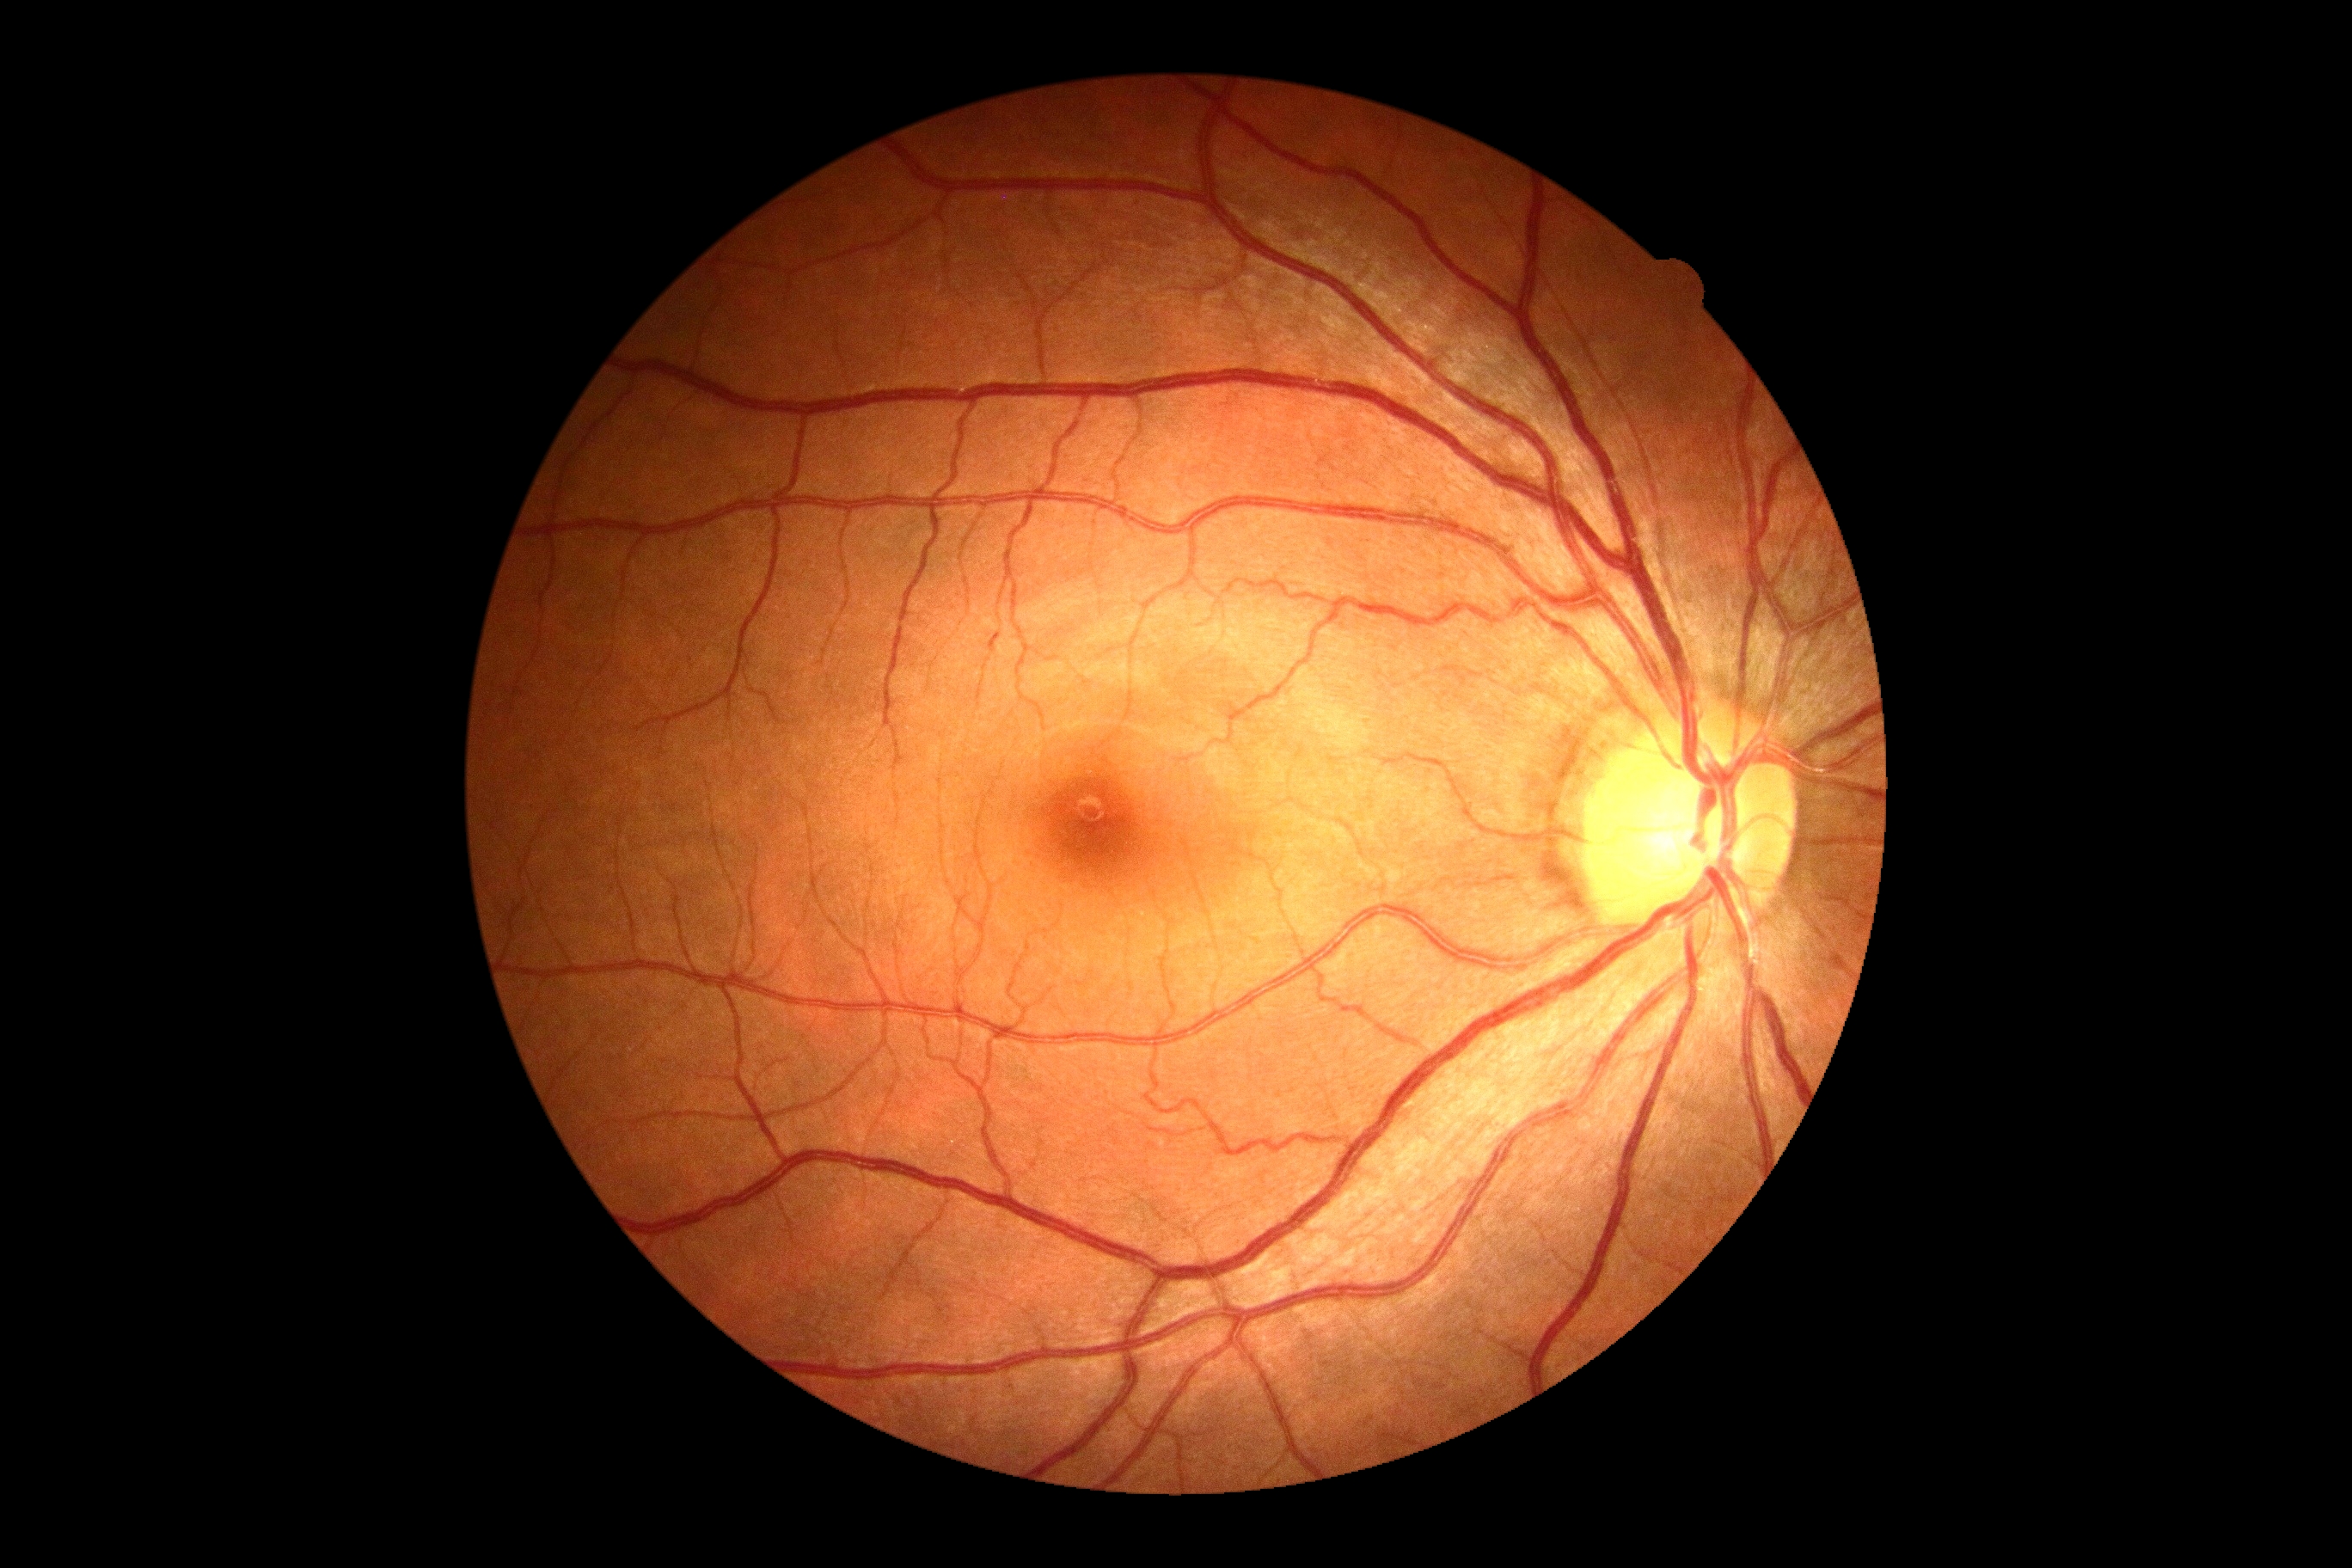 Diabetic retinopathy (DR): 0/4.